Image size 1932x1932 · fundus photo.
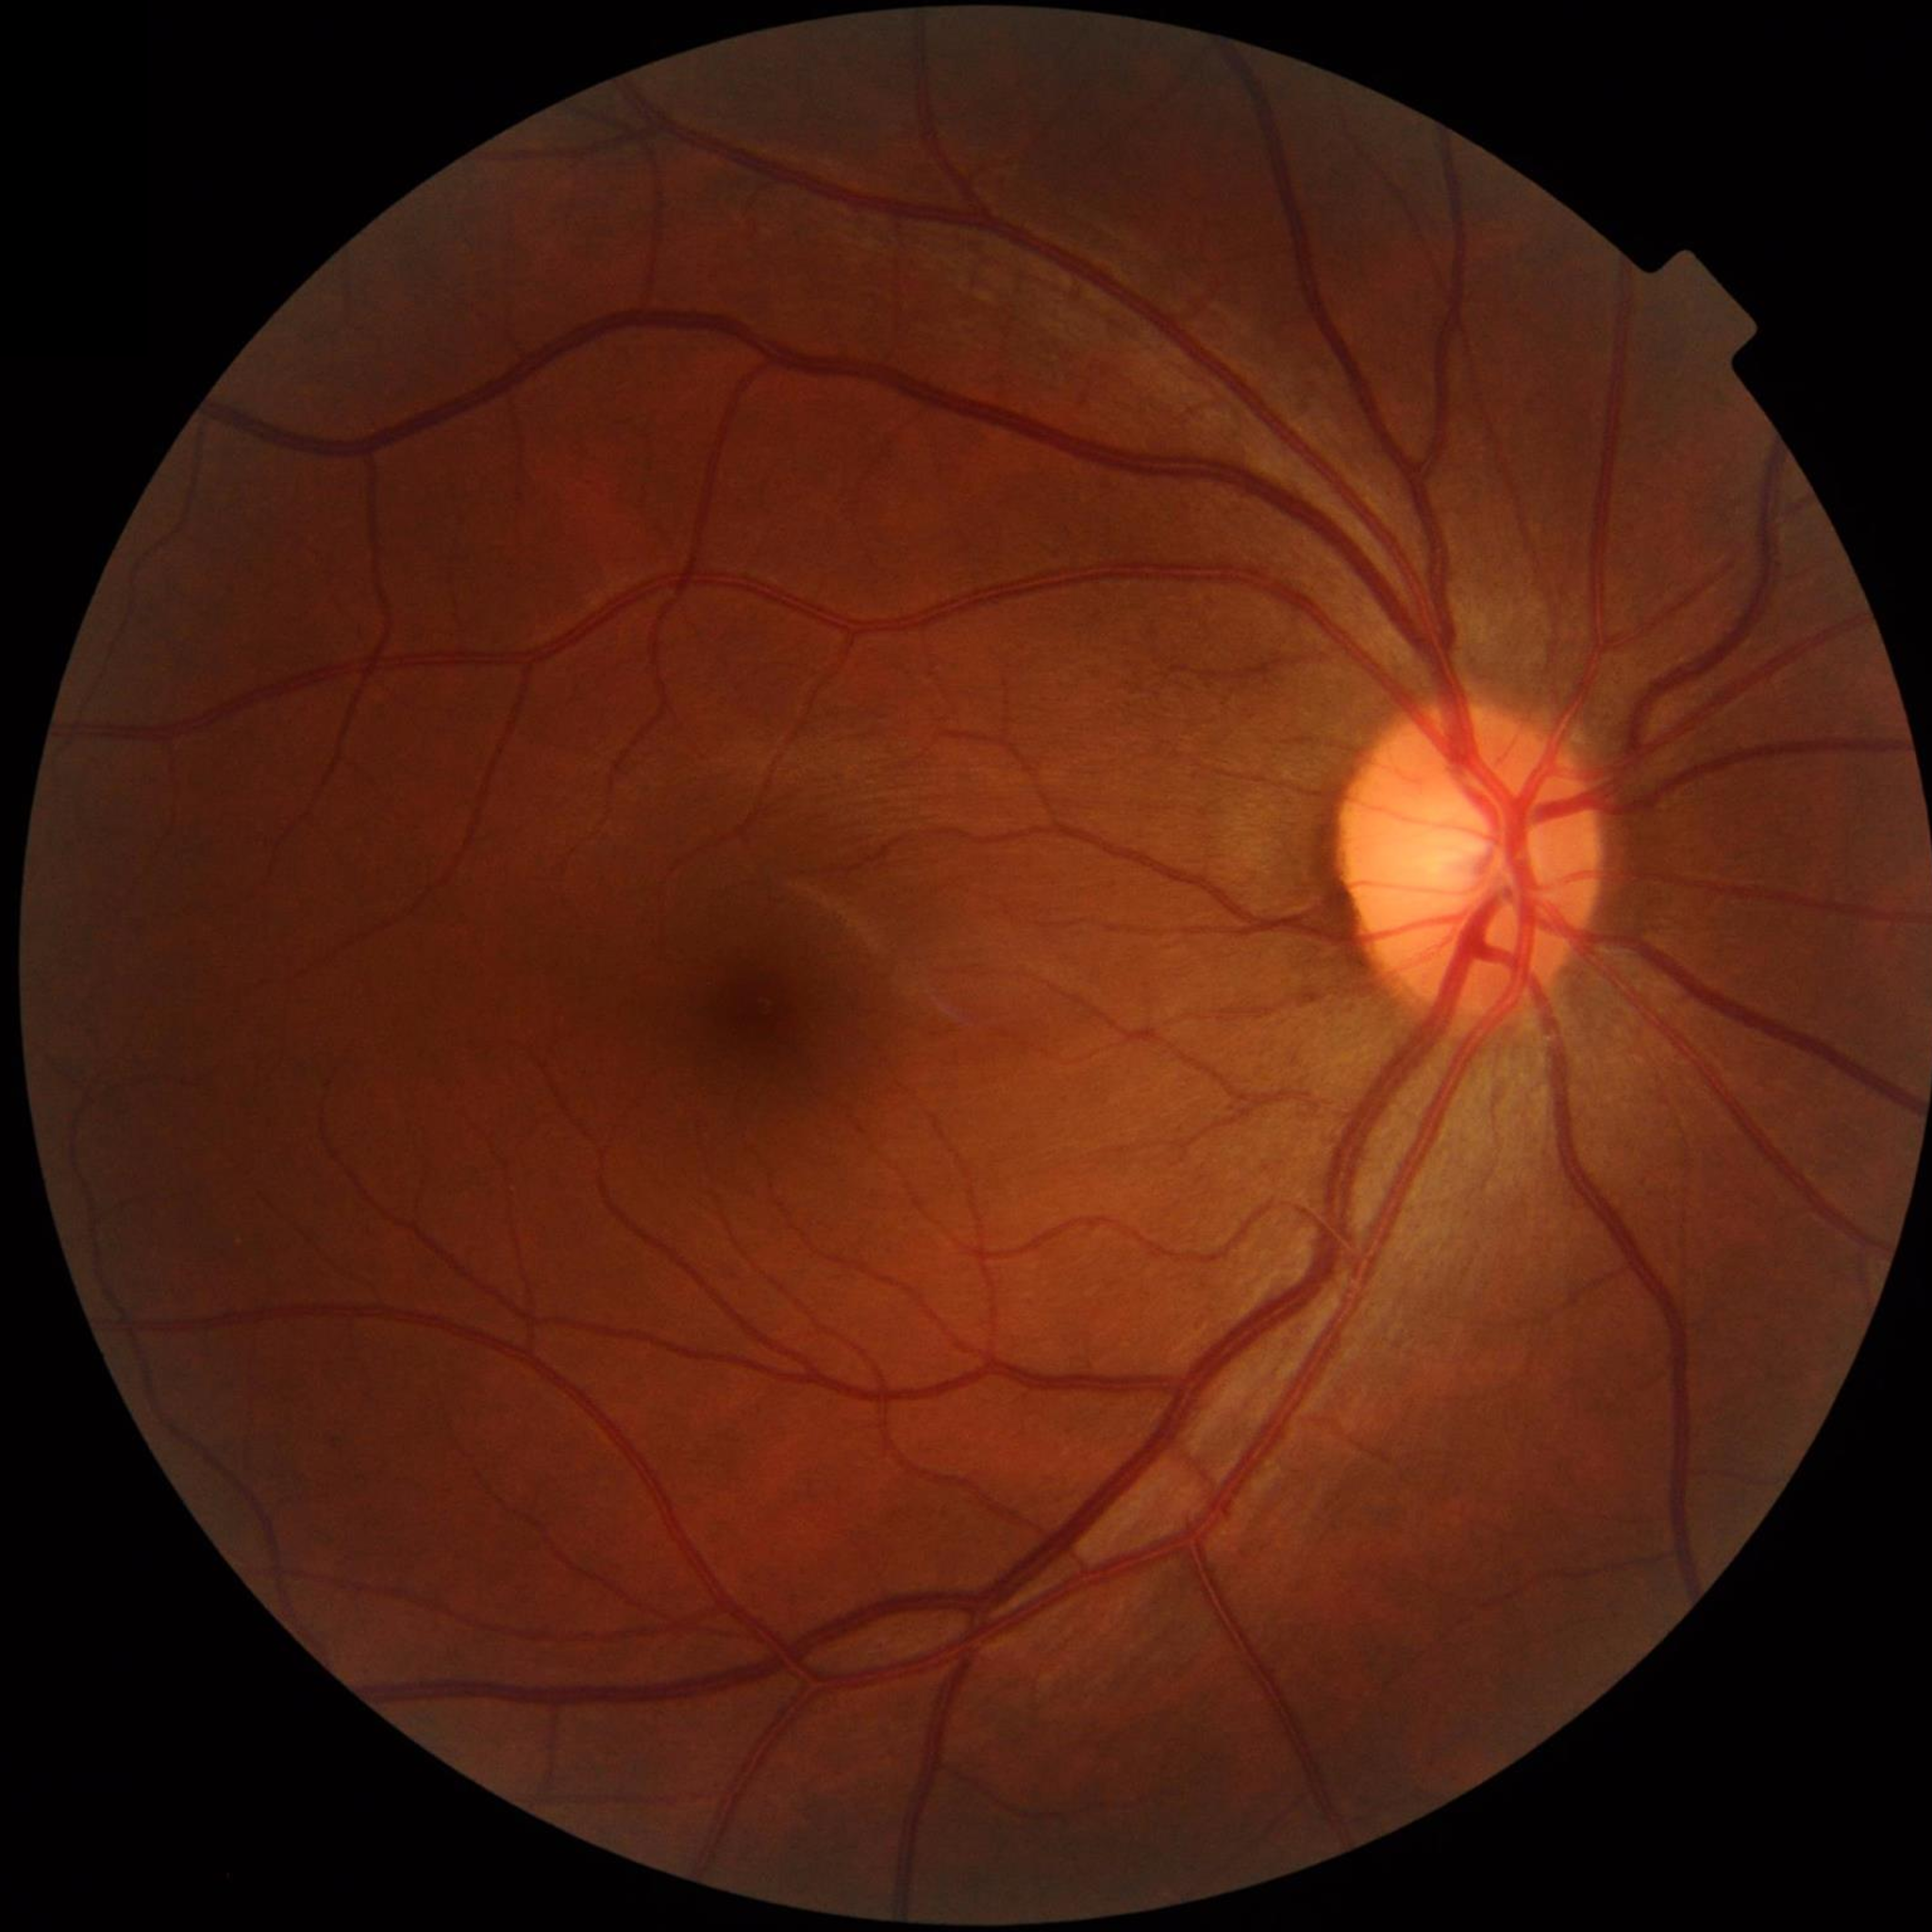
Control patient without diagnosed AMD, DR, or glaucoma.